640x480px. Captured with the Clarity RetCam 3 (130° field of view). Pediatric retinal photograph (wide-field): 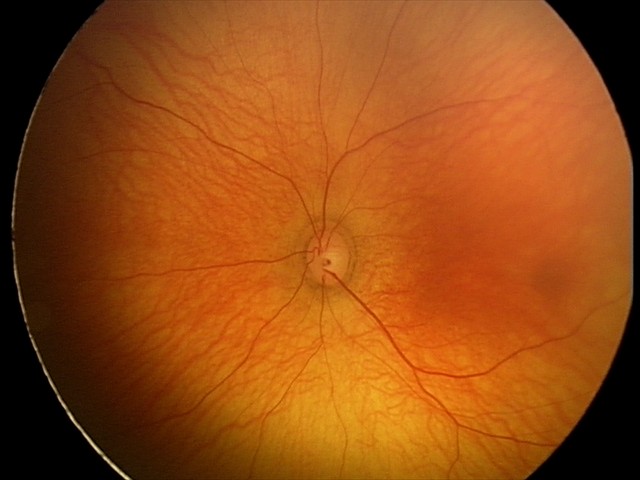 Physiological retinal appearance for postconceptual age.